848x848px; no pharmacologic dilation; color fundus image
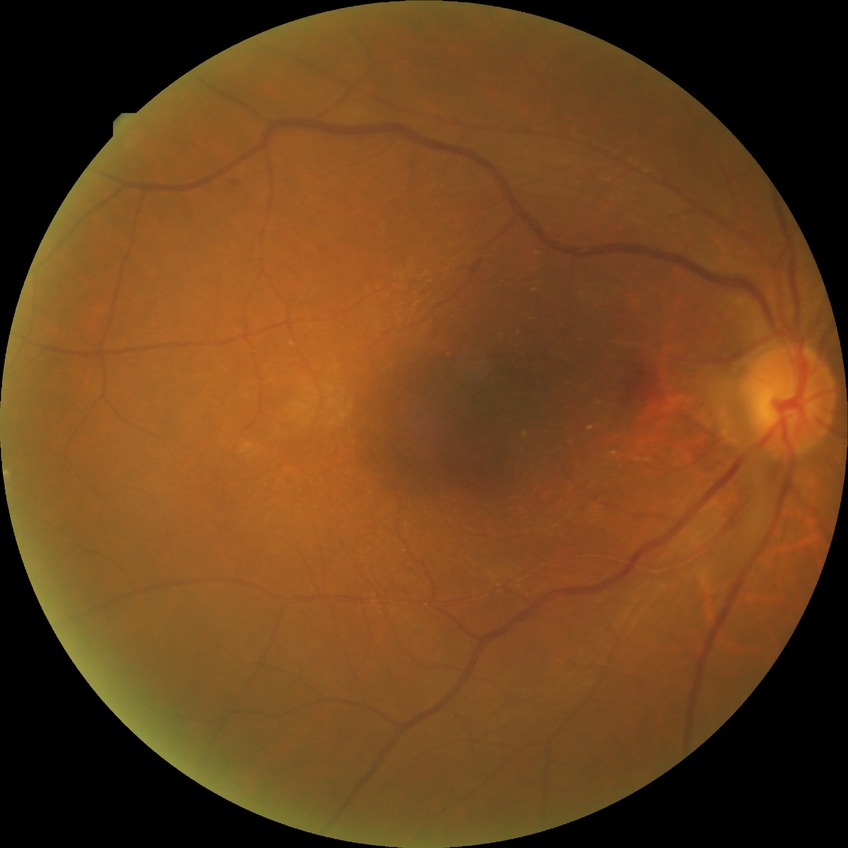
Disease class: non-proliferative diabetic retinopathy. Diabetic retinopathy (DR) is SDR (simple diabetic retinopathy).